1440 x 1080 pixels · wide-field contact fundus photograph of an infant — 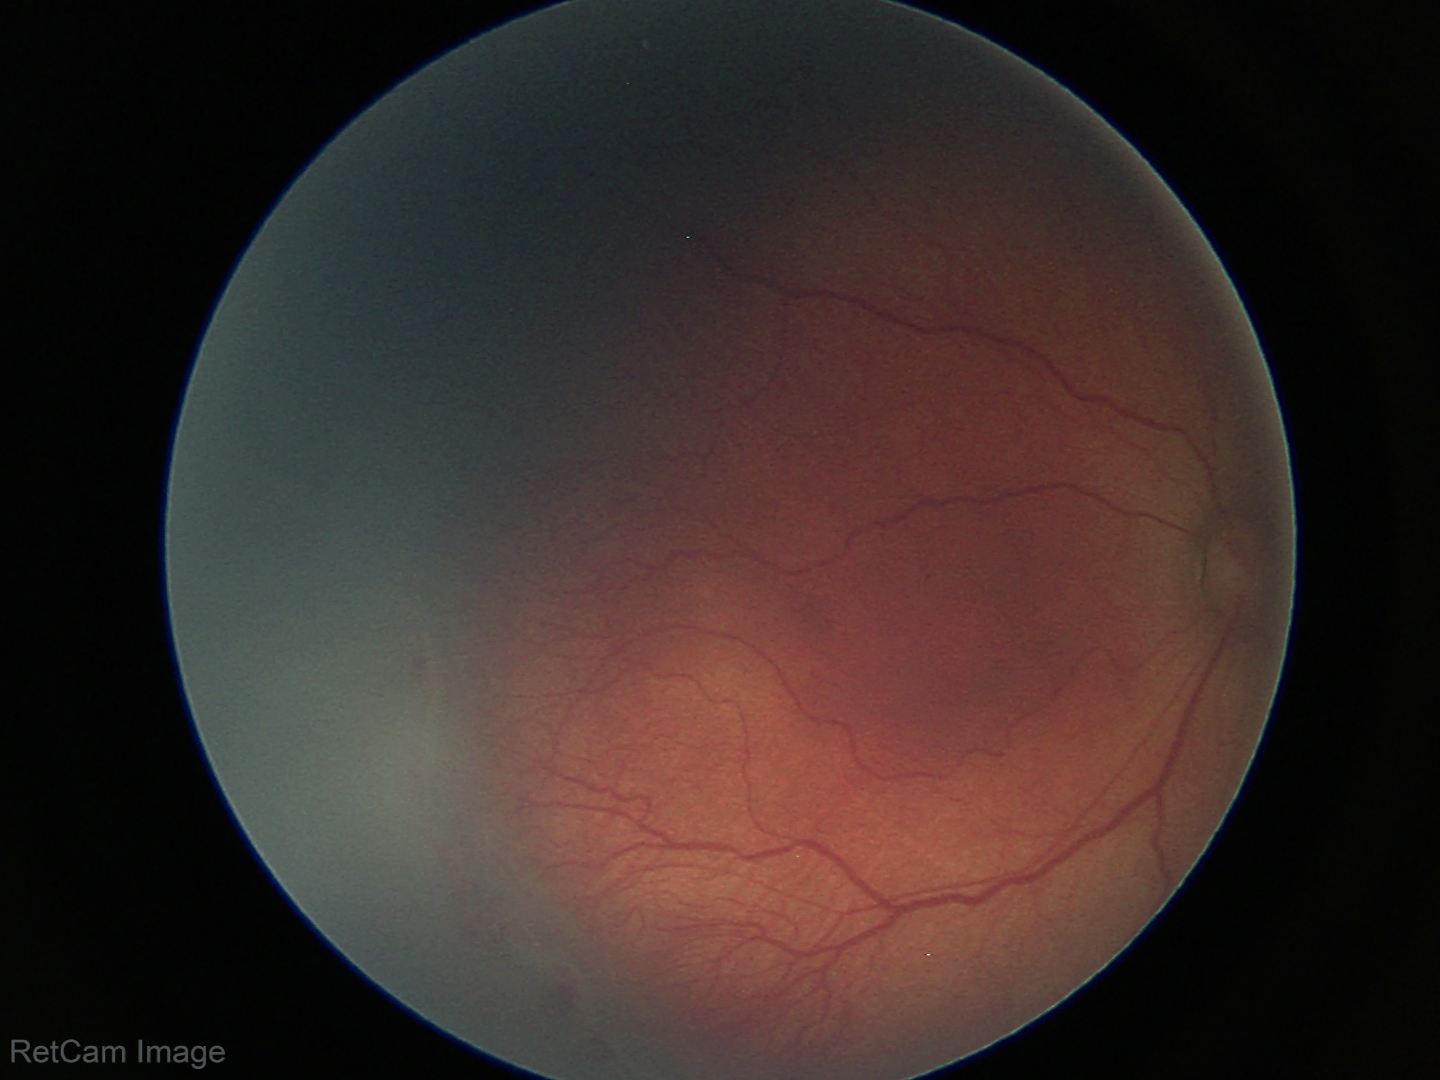

Diagnosis from this screening exam: ROP stage 2.